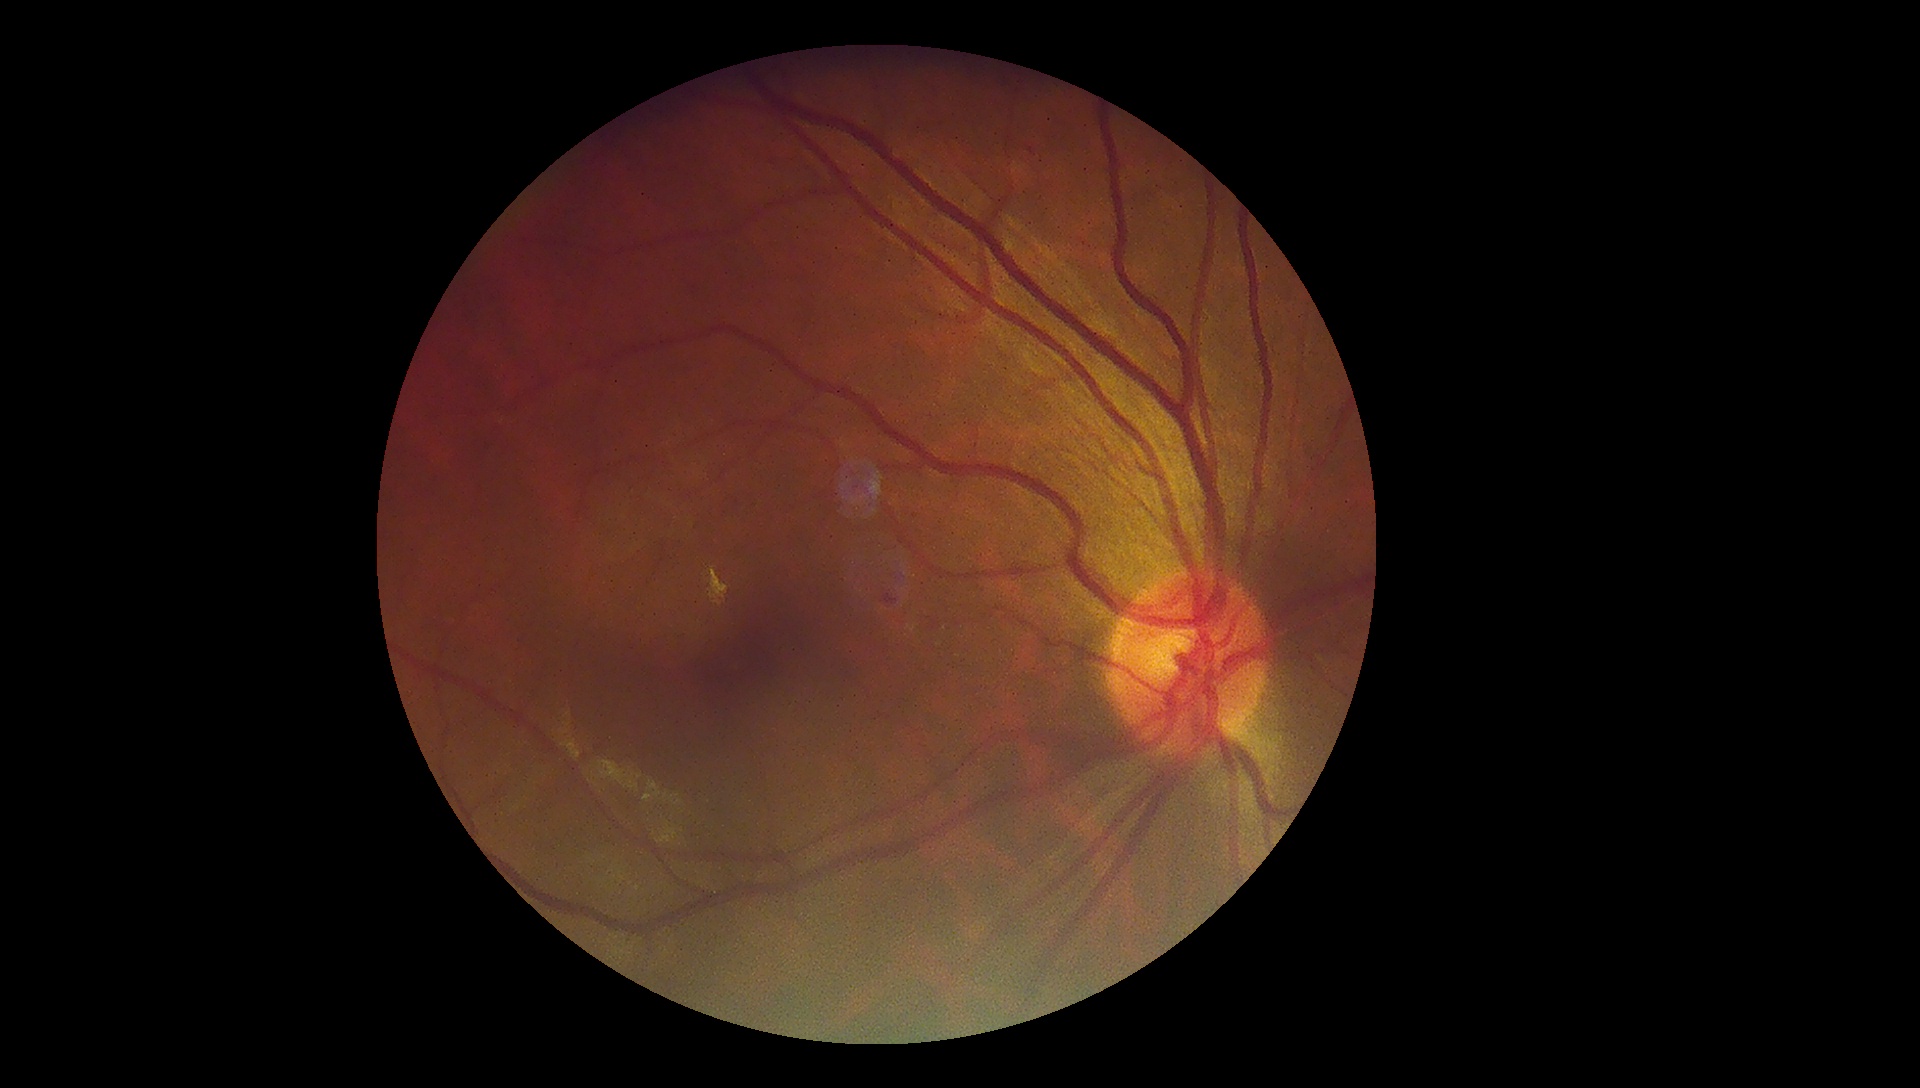

{
  "dr_grade": "2"
}